45° field of view — 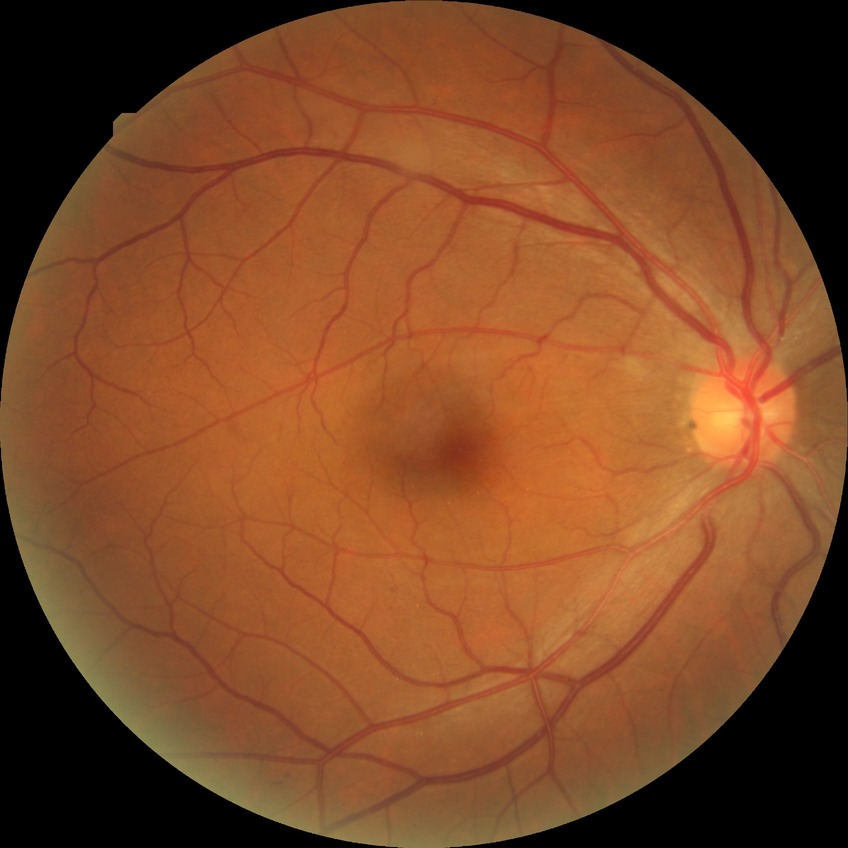

Davis grading is simple diabetic retinopathy.